Color fundus image; 512x512px: 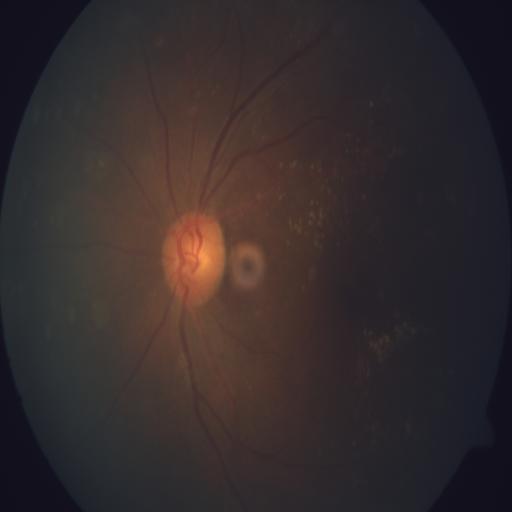

Impression: drusen (DN).